848 x 848 pixels. No pharmacologic dilation. Color fundus photograph. DR severity per modified Davis staging. NIDEK AFC-230 fundus camera.
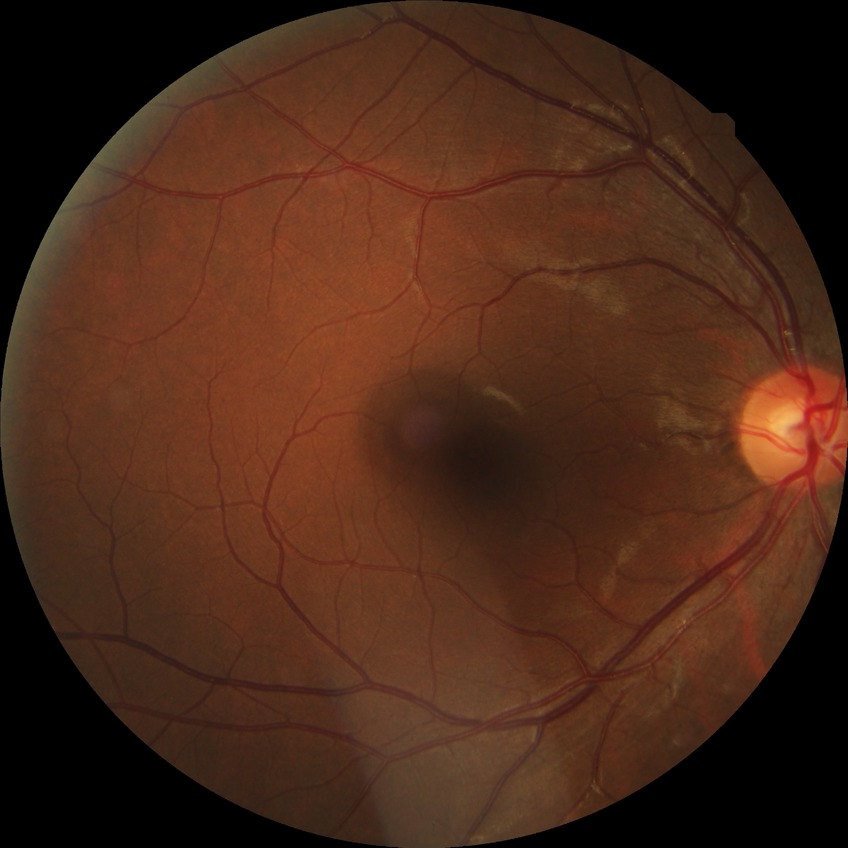 diabetic retinopathy (DR) = NDR (no diabetic retinopathy).